Mydriatic (tropicamide 0.5%). 50° field of view. Retinal fundus photograph. 2361x1568 — 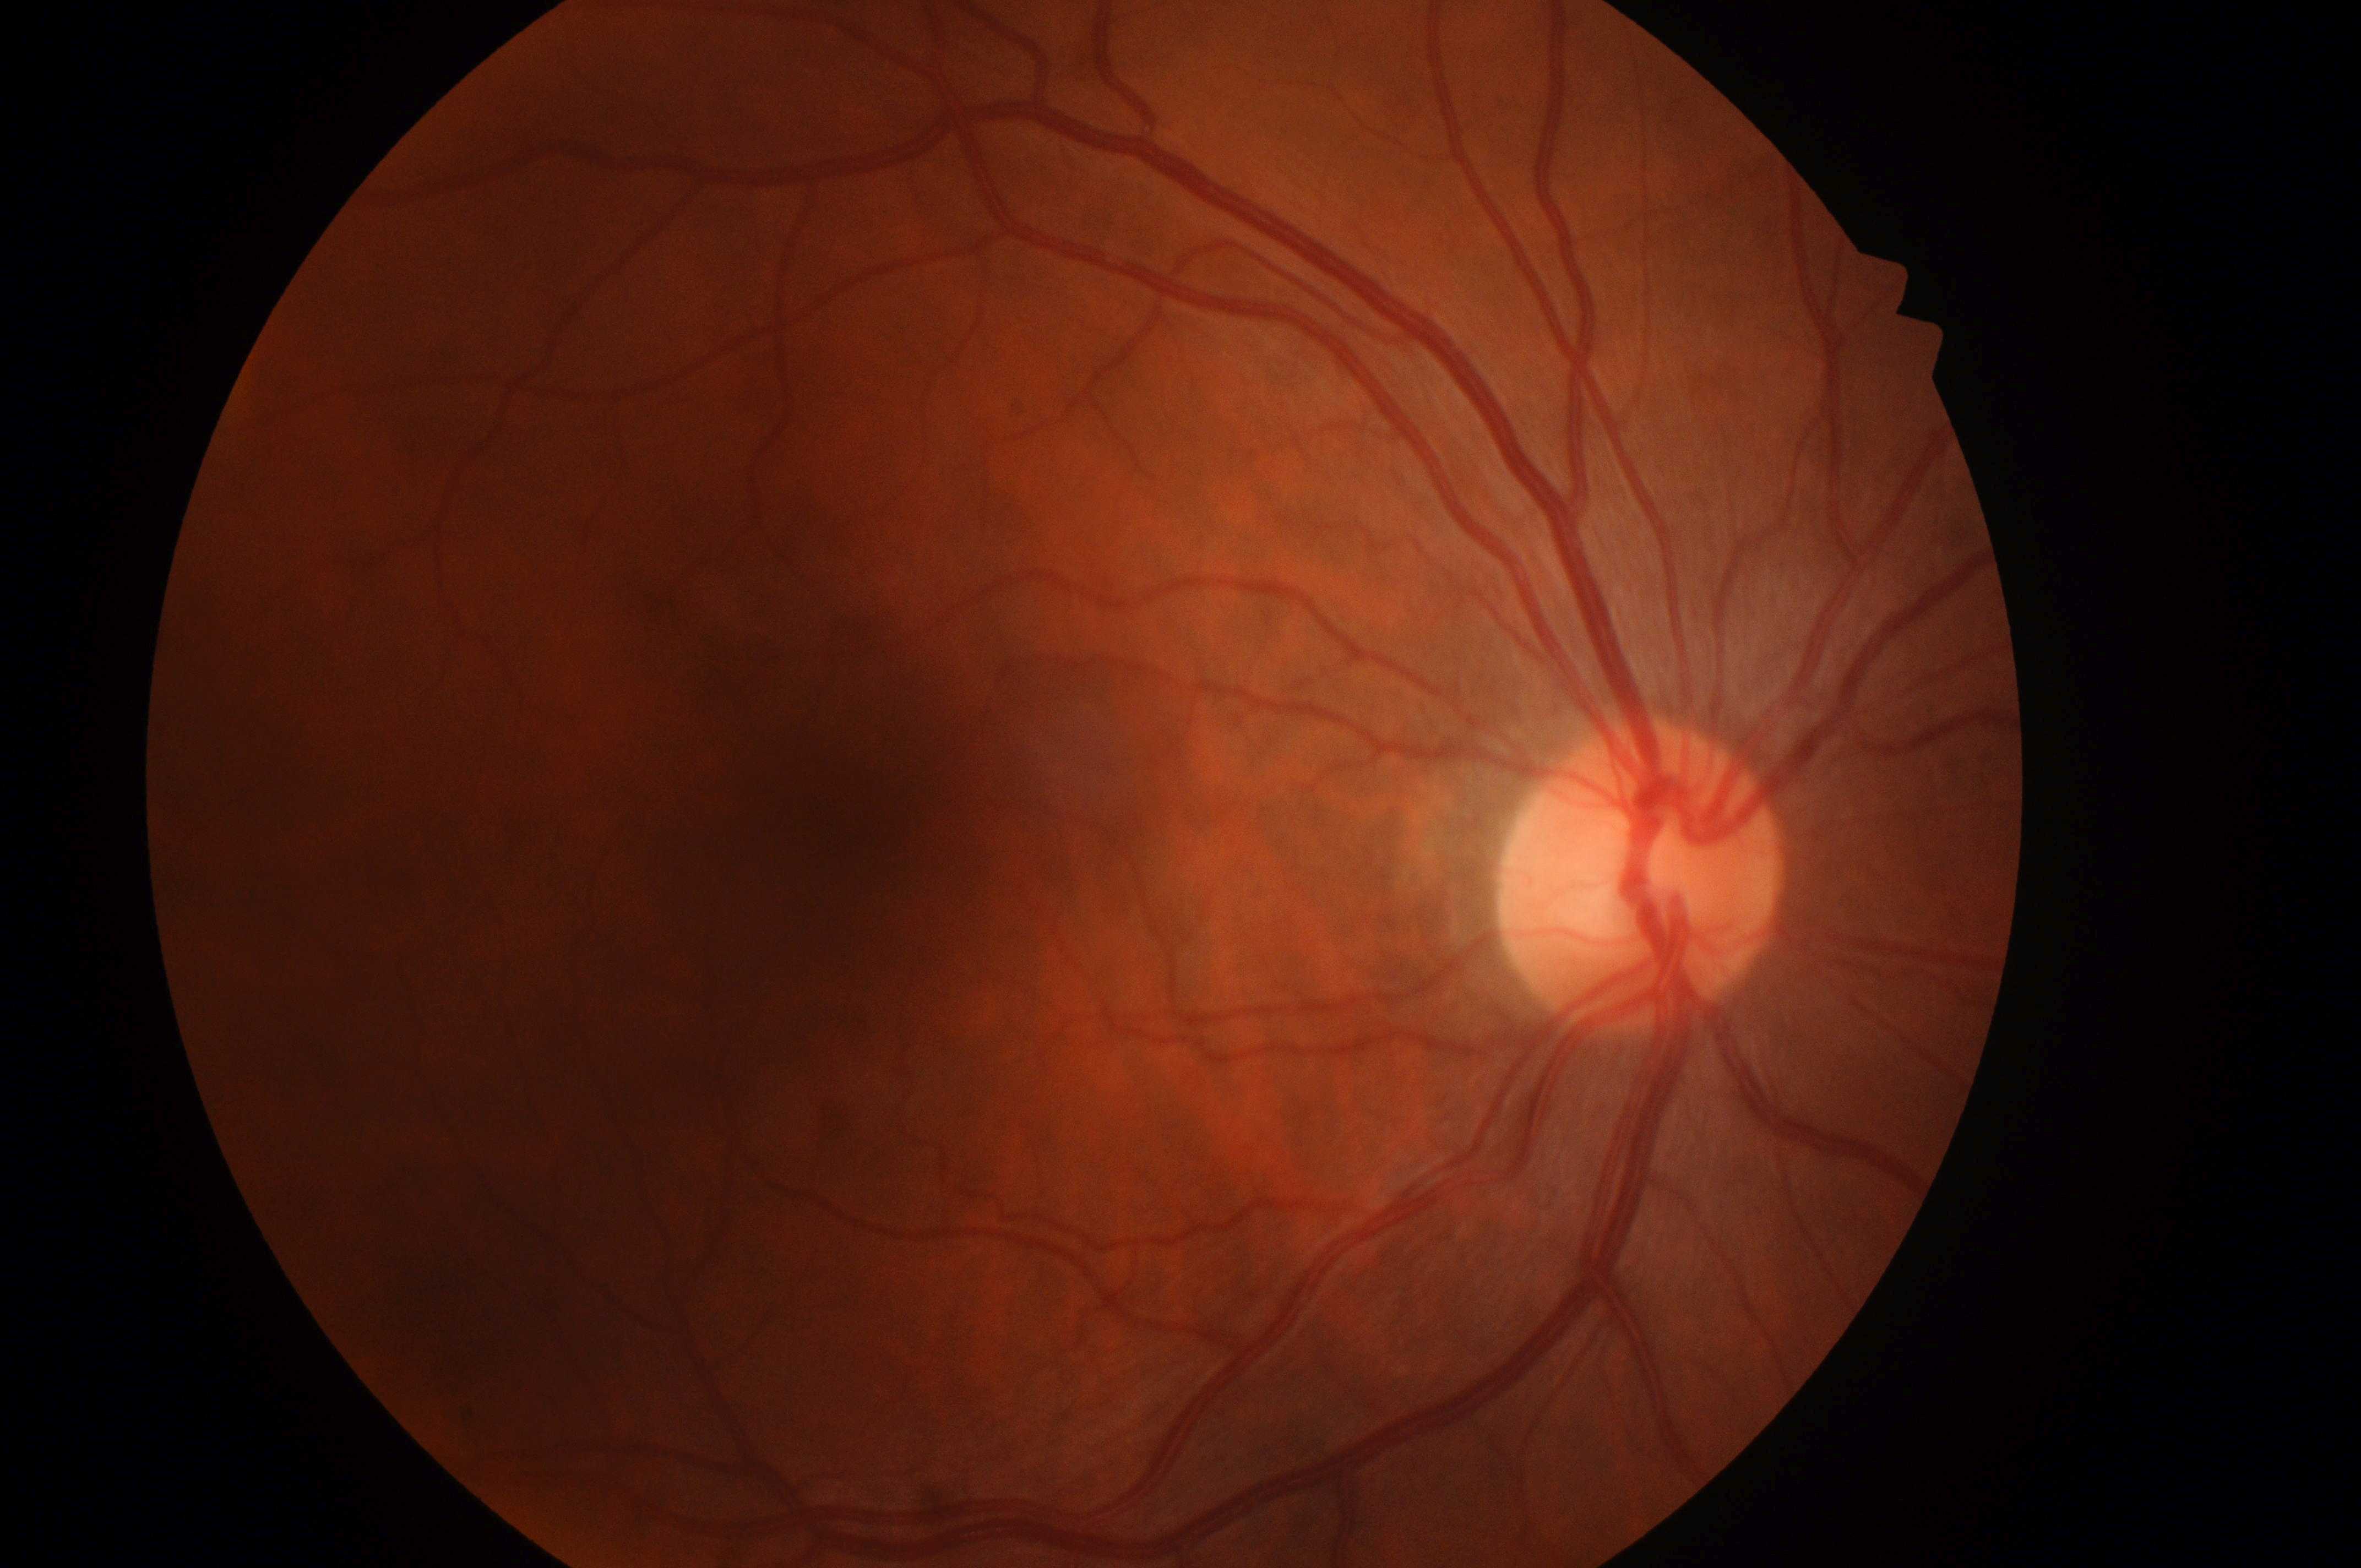
Diabetic retinopathy: no apparent diabetic retinopathy (grade 0). The optic nerve head is at (x: 1634, y: 890). Fovea located at (x: 835, y: 831). No DR or DME findings. The image shows the oculus dexter. Risk of macular edema: no risk (grade 0).